DR severity per modified Davis staging · 45° field of view · camera: NIDEK AFC-230 — 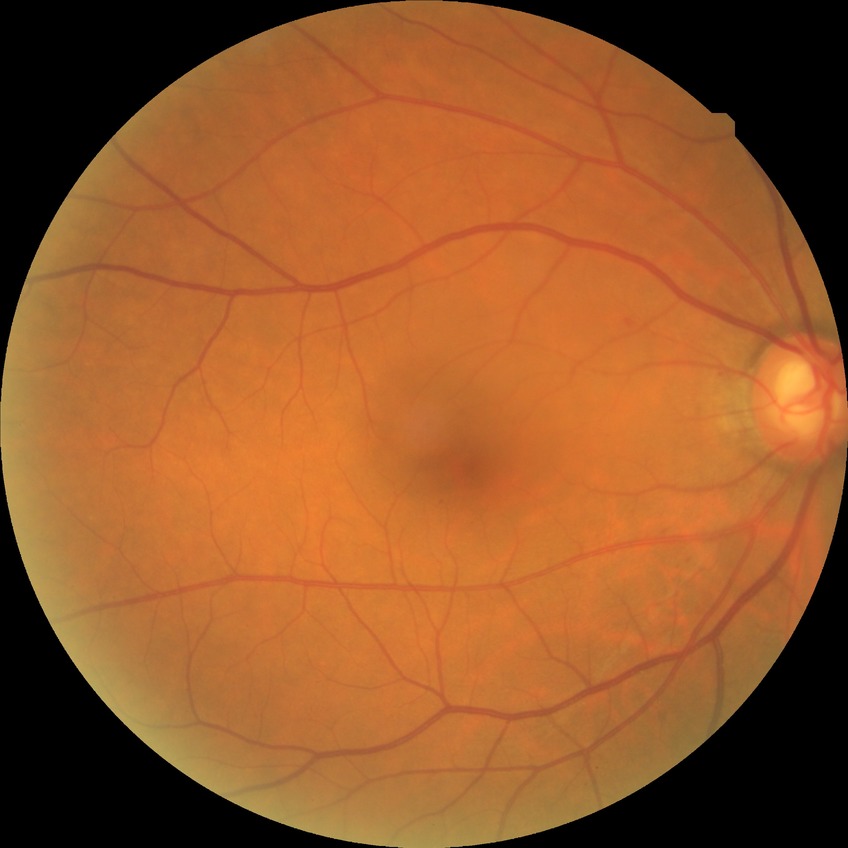

diabetic retinopathy grade = no diabetic retinopathy